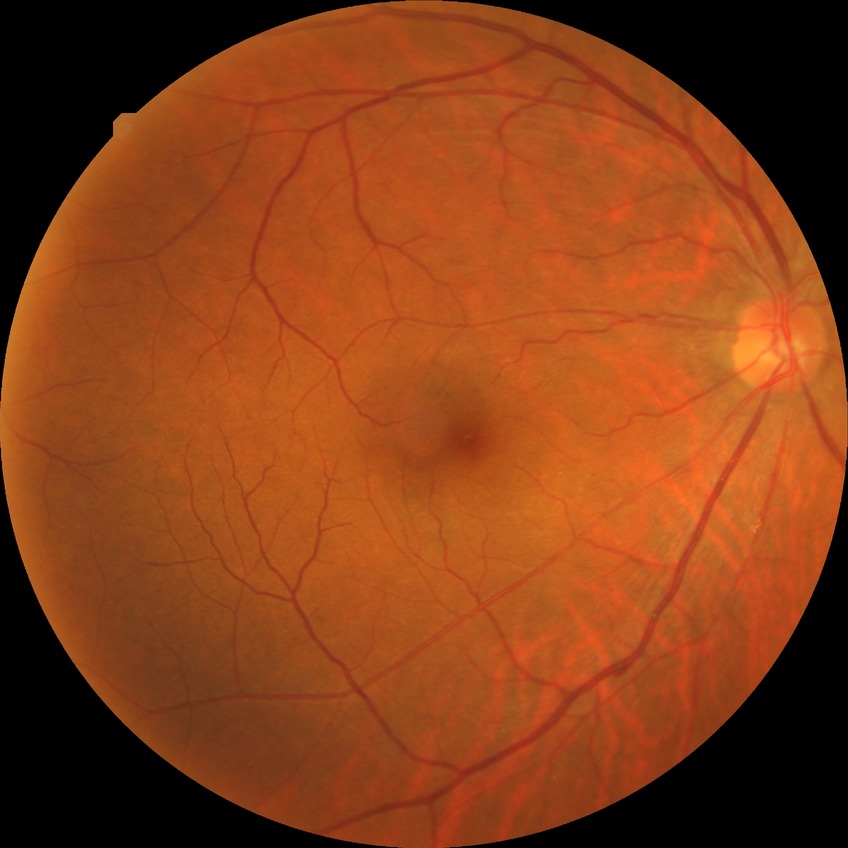

Assessment:
- diabetic retinopathy severity: no diabetic retinopathy